130° field of view (Clarity RetCam 3). RetCam wide-field infant fundus image. 640x480px.
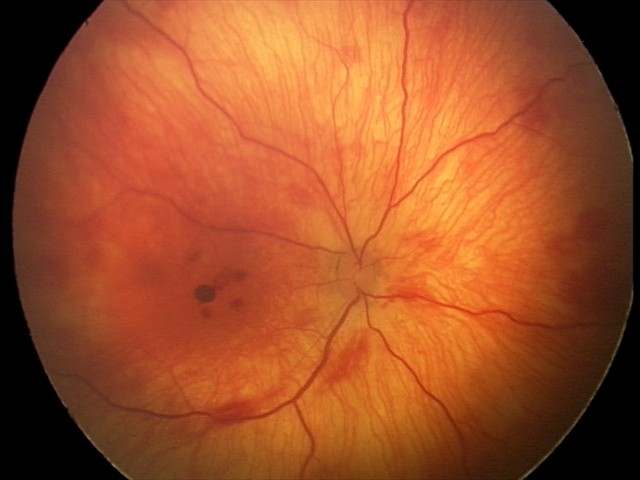

Screening series with retinal hemorrhages.